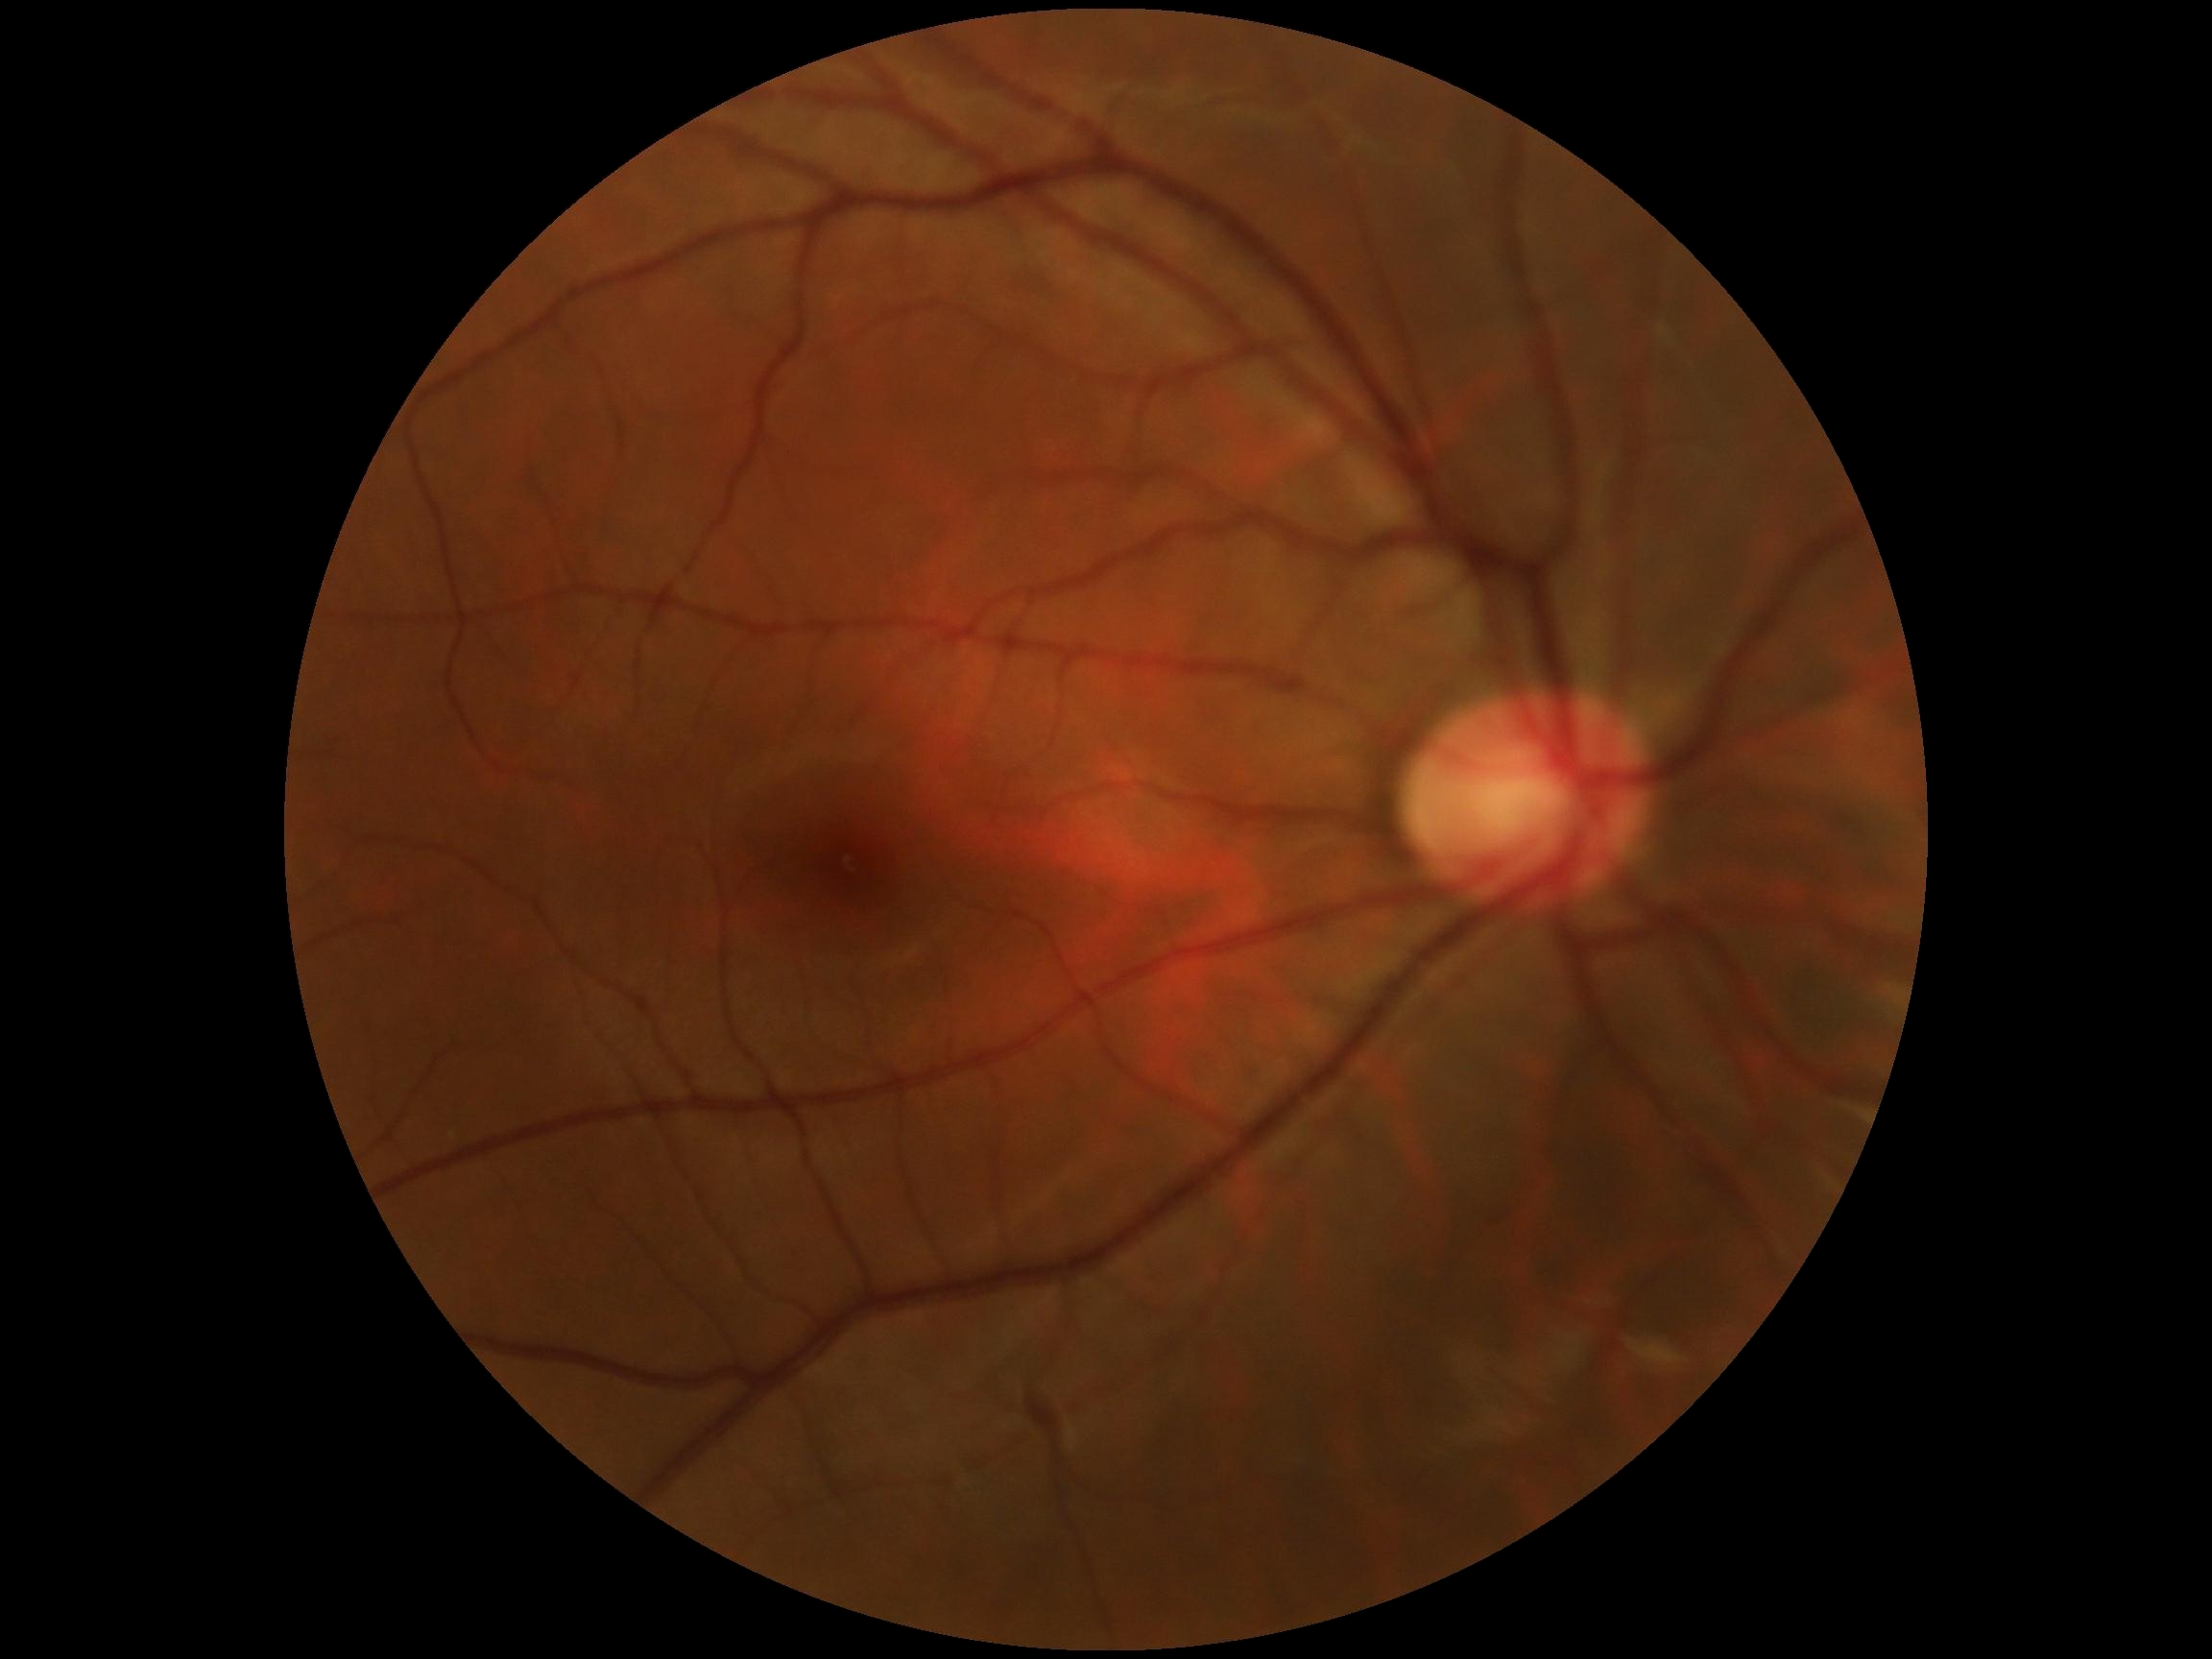 DR severity = grade 0